55-year-old patient. Refractive error: sphere +1 D, cylinder -0.25 D, axis 170°. Woman.
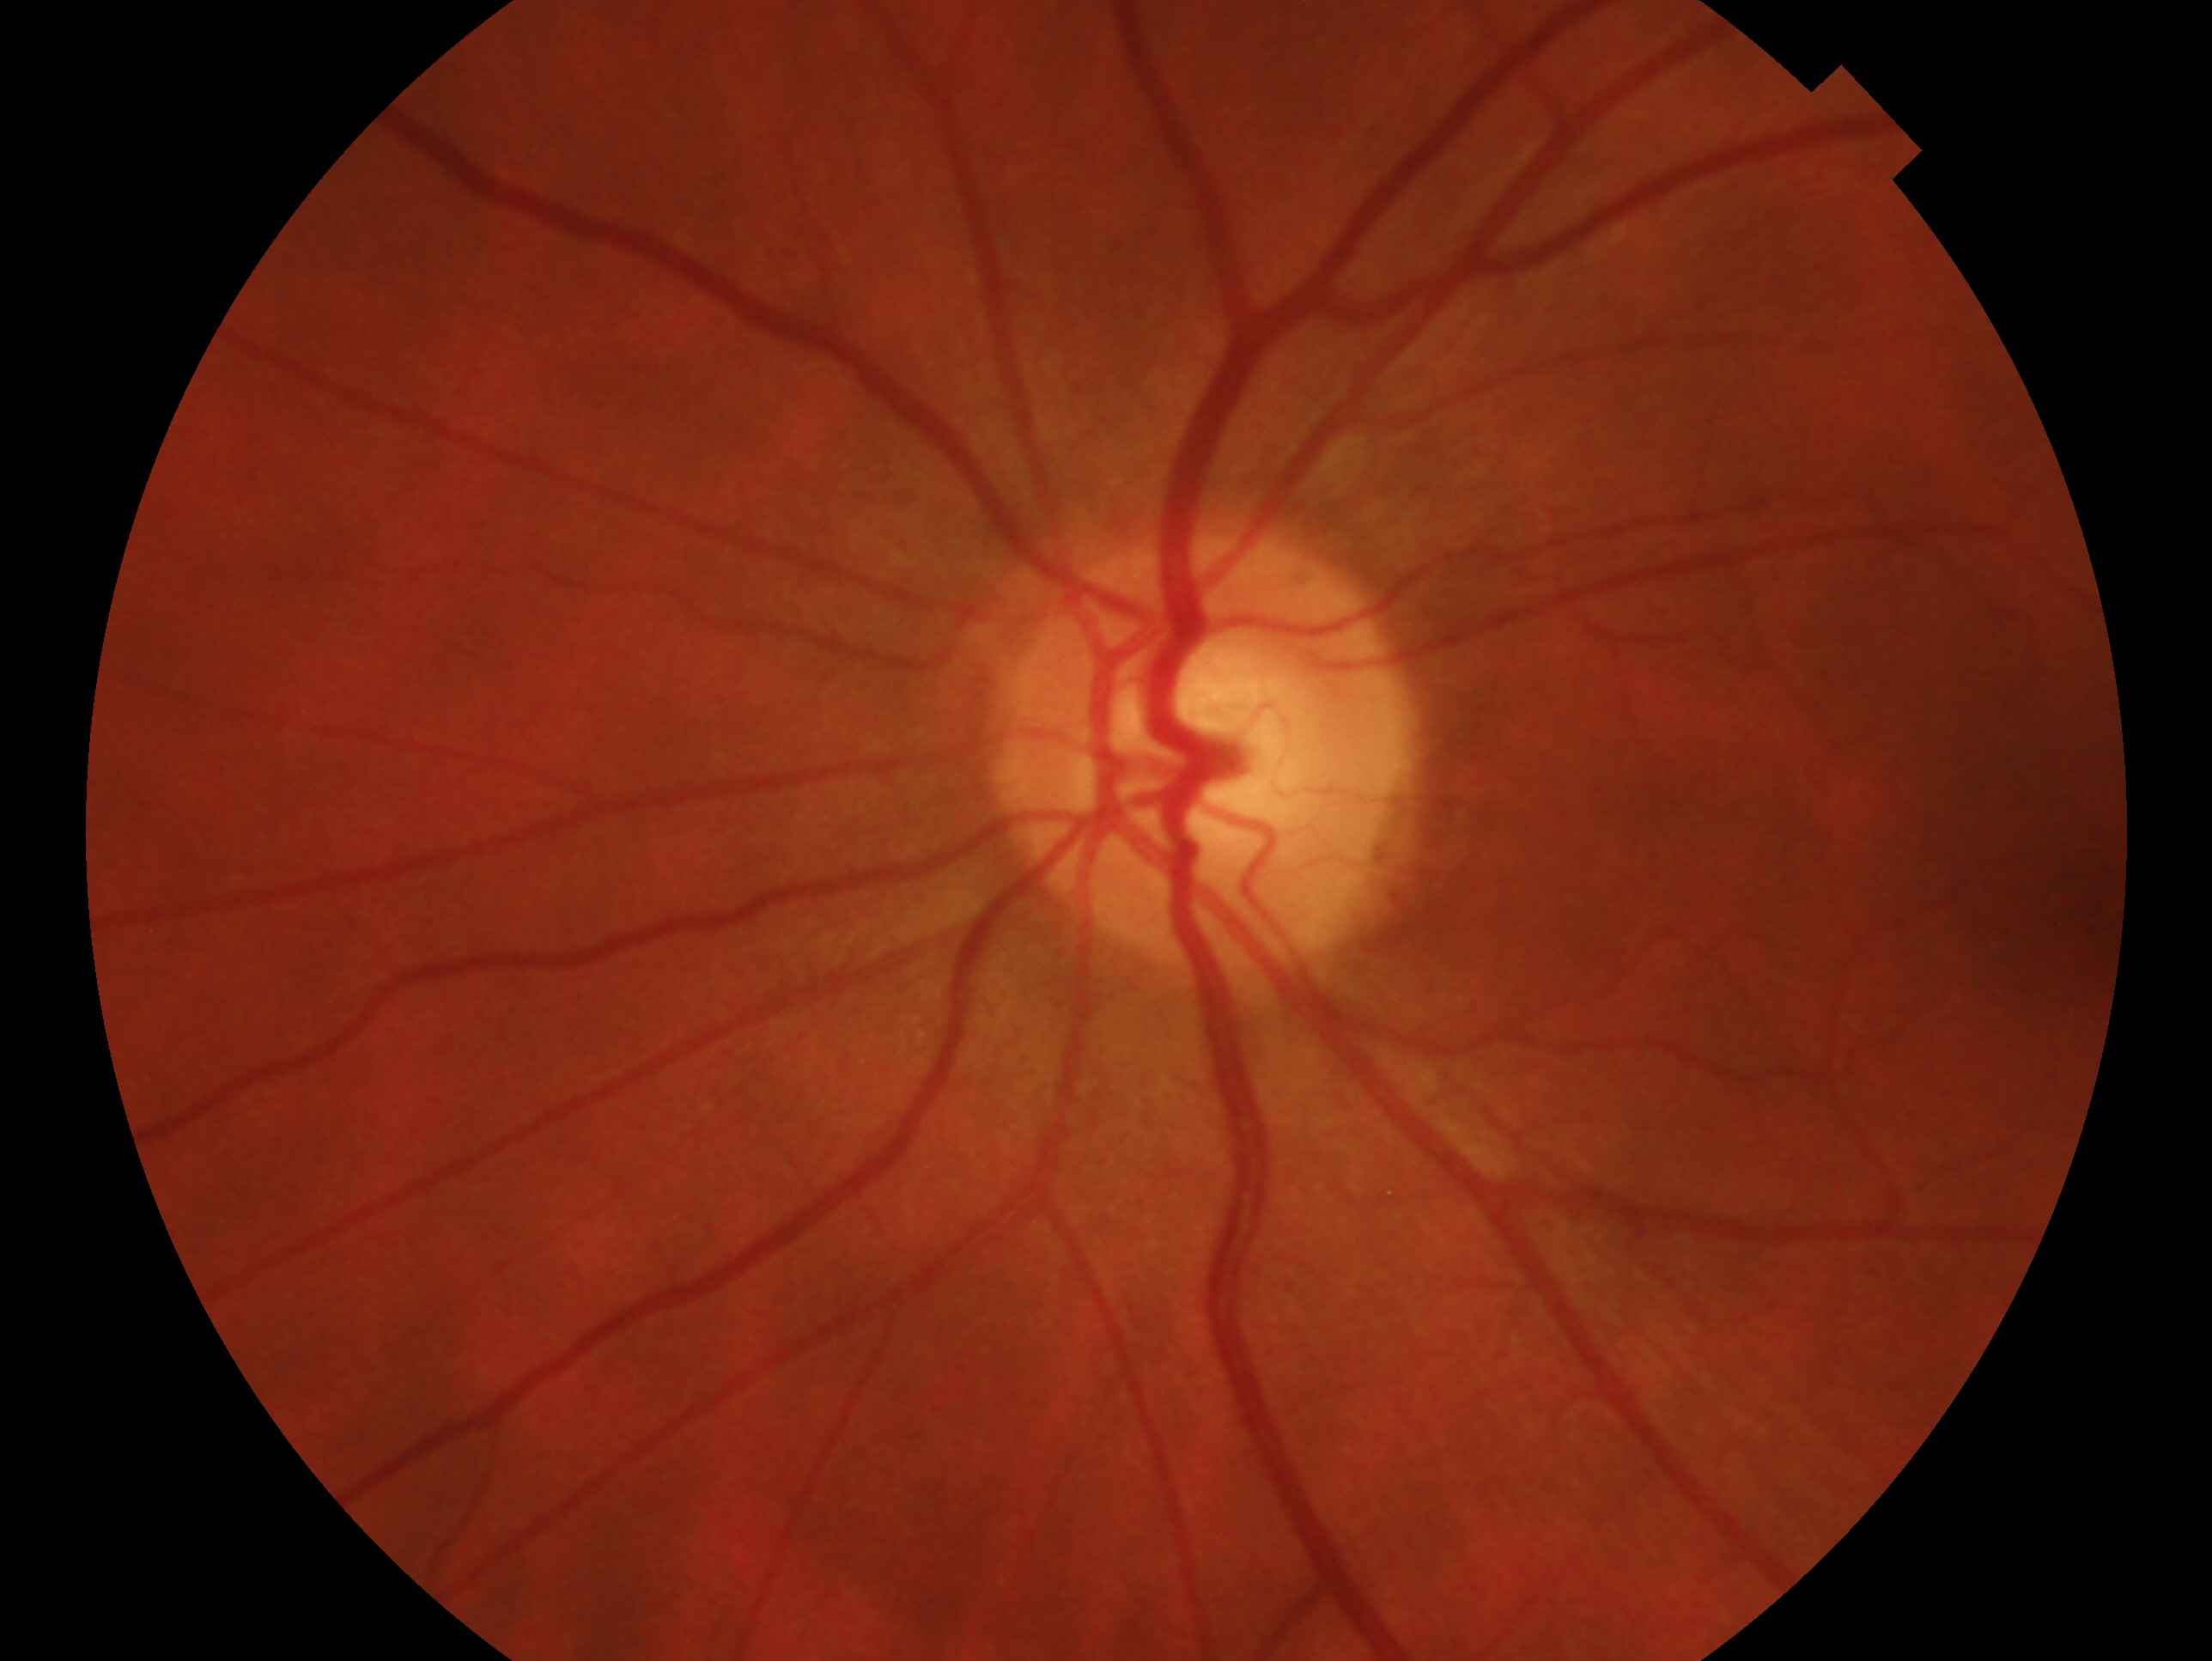

laterality: left eye, glaucoma diagnosis: no glaucoma — no clinical evidence of glaucoma in this eye.